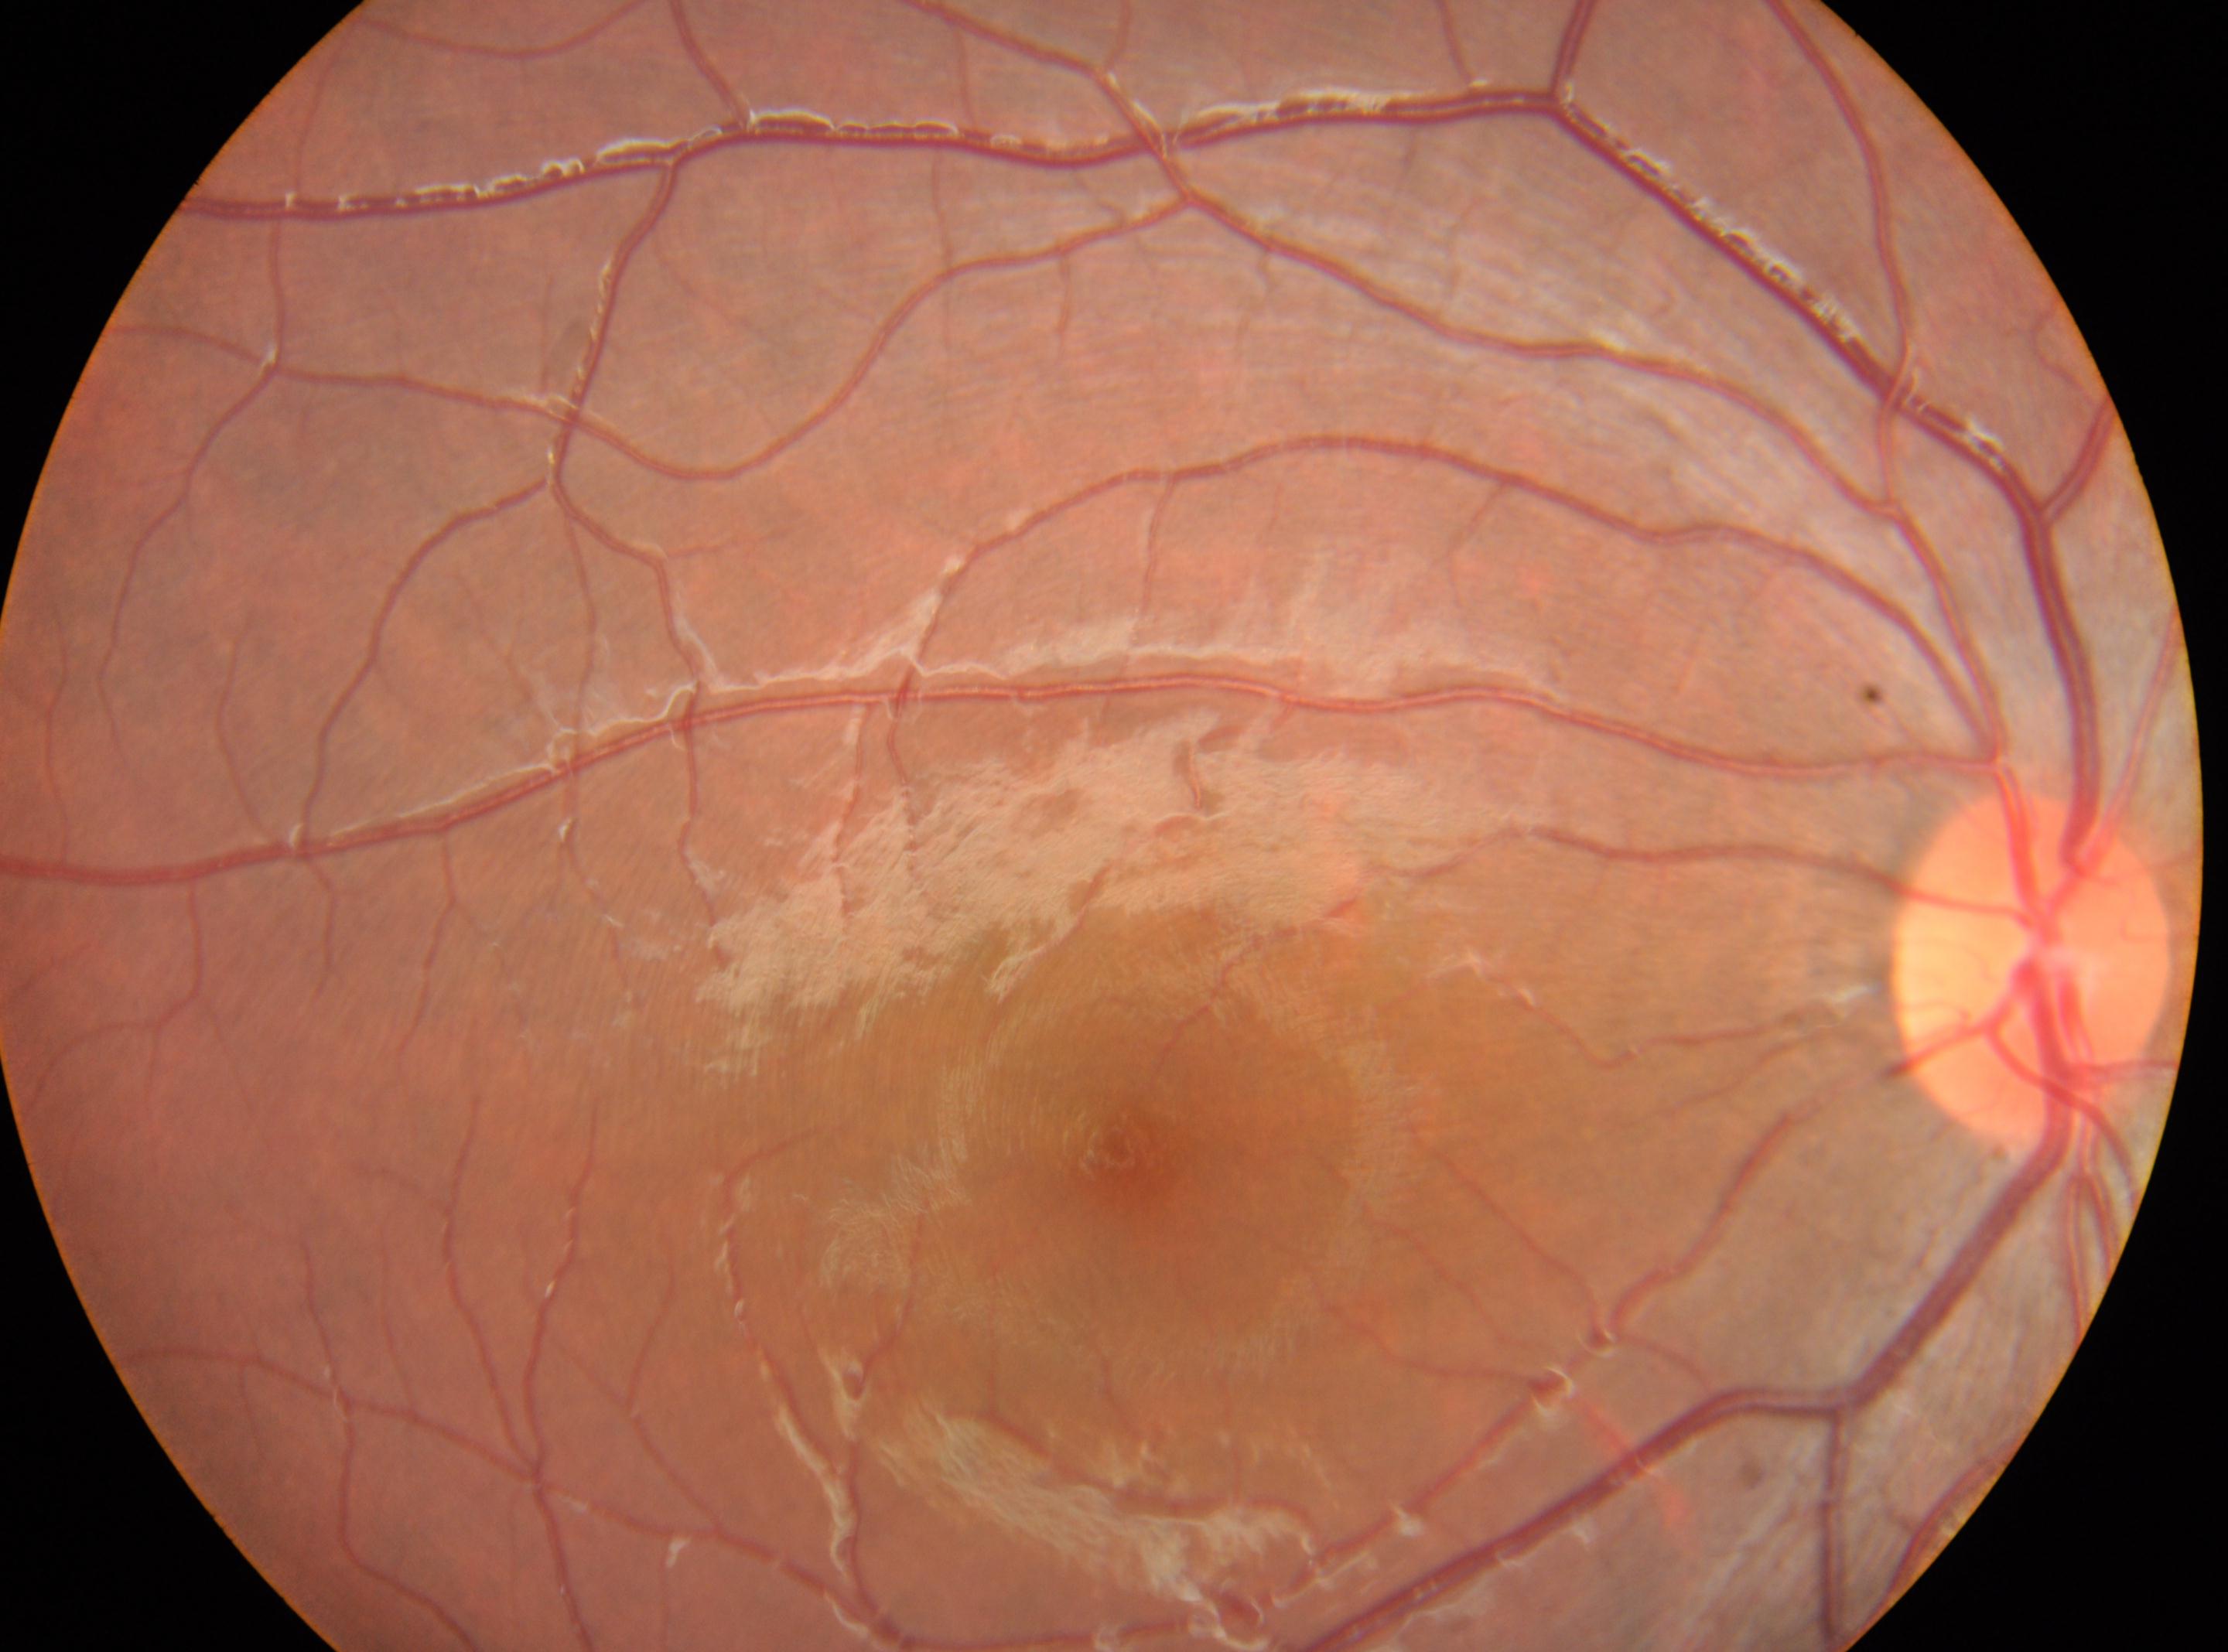 Q: Fovea center?
A: (1136, 1160)
Q: Optic disc center?
A: (2032, 963)
Q: Right or left eye?
A: OD
Q: What is the DR grade?
A: grade 0